45-degree field of view, color fundus image:
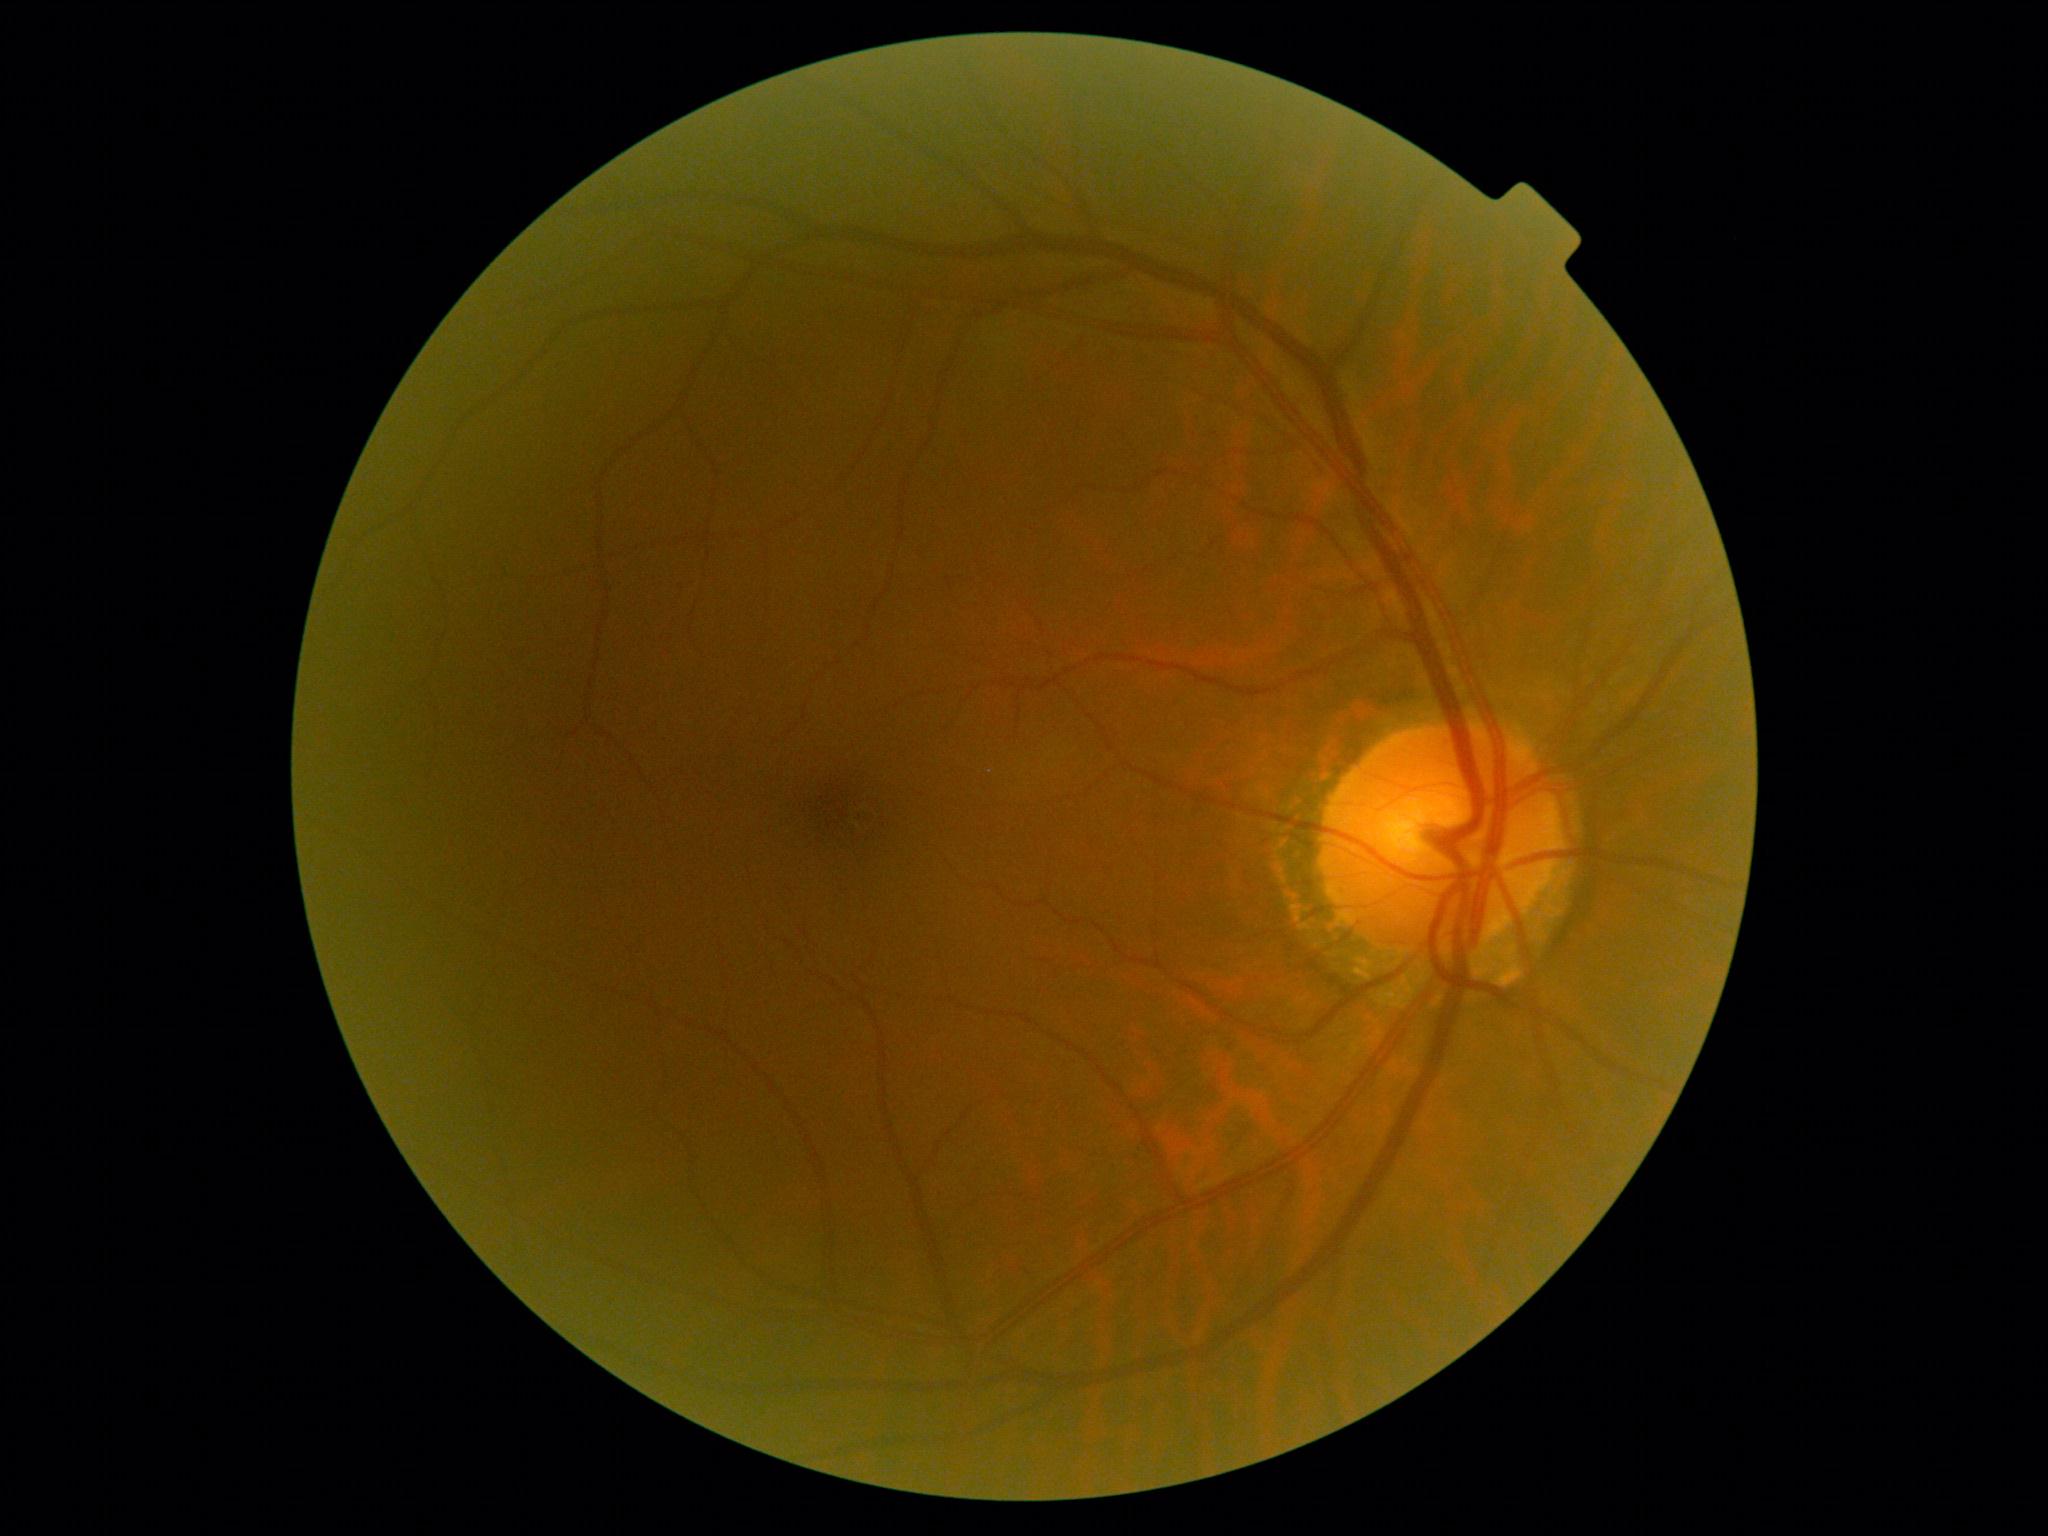
No DR findings. DR severity: no apparent retinopathy (grade 0).